848x848px. CFP. DR severity per modified Davis staging.
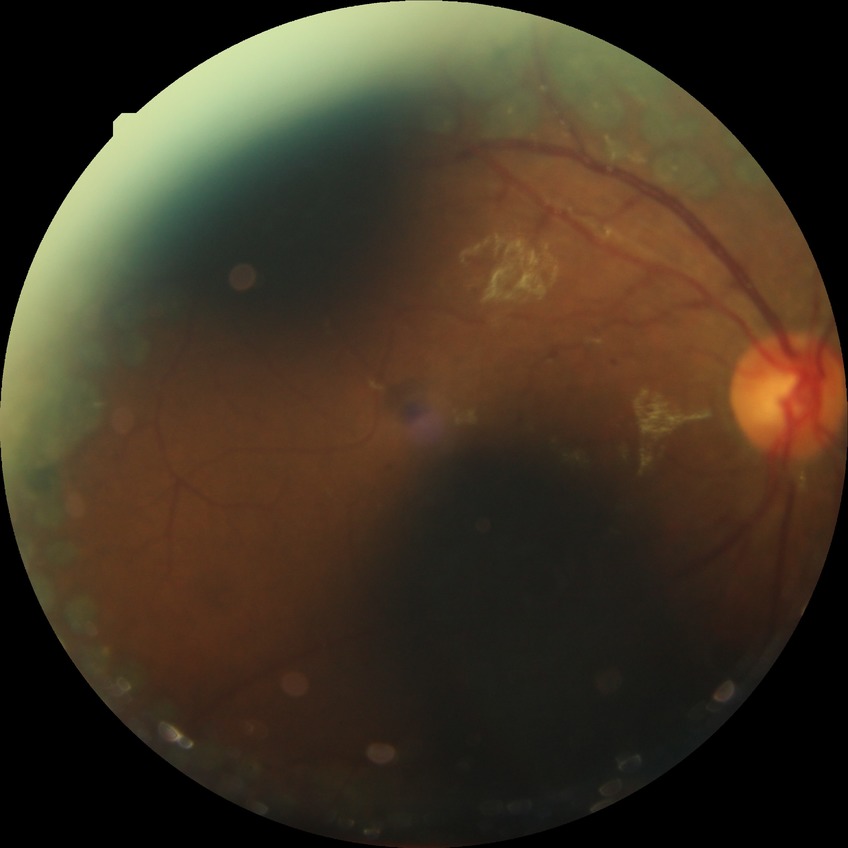
diabetic retinopathy (DR) = PDR (proliferative diabetic retinopathy).